45° FOV. 848 x 848 pixels. Fundus photo:
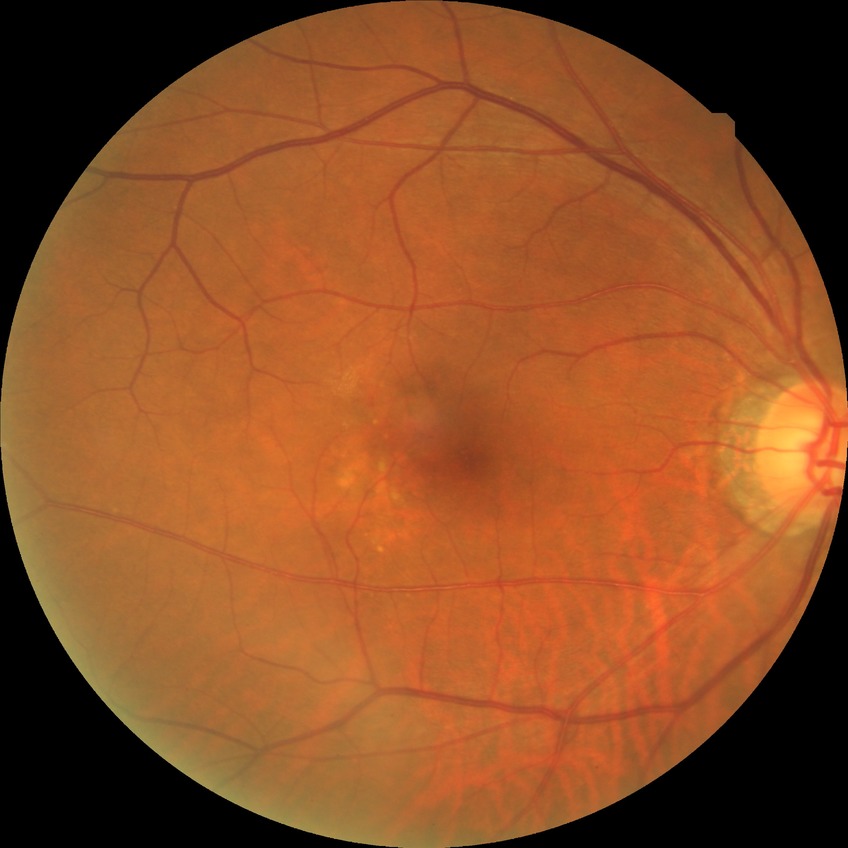

Diabetic retinopathy (DR) is no diabetic retinopathy (NDR).